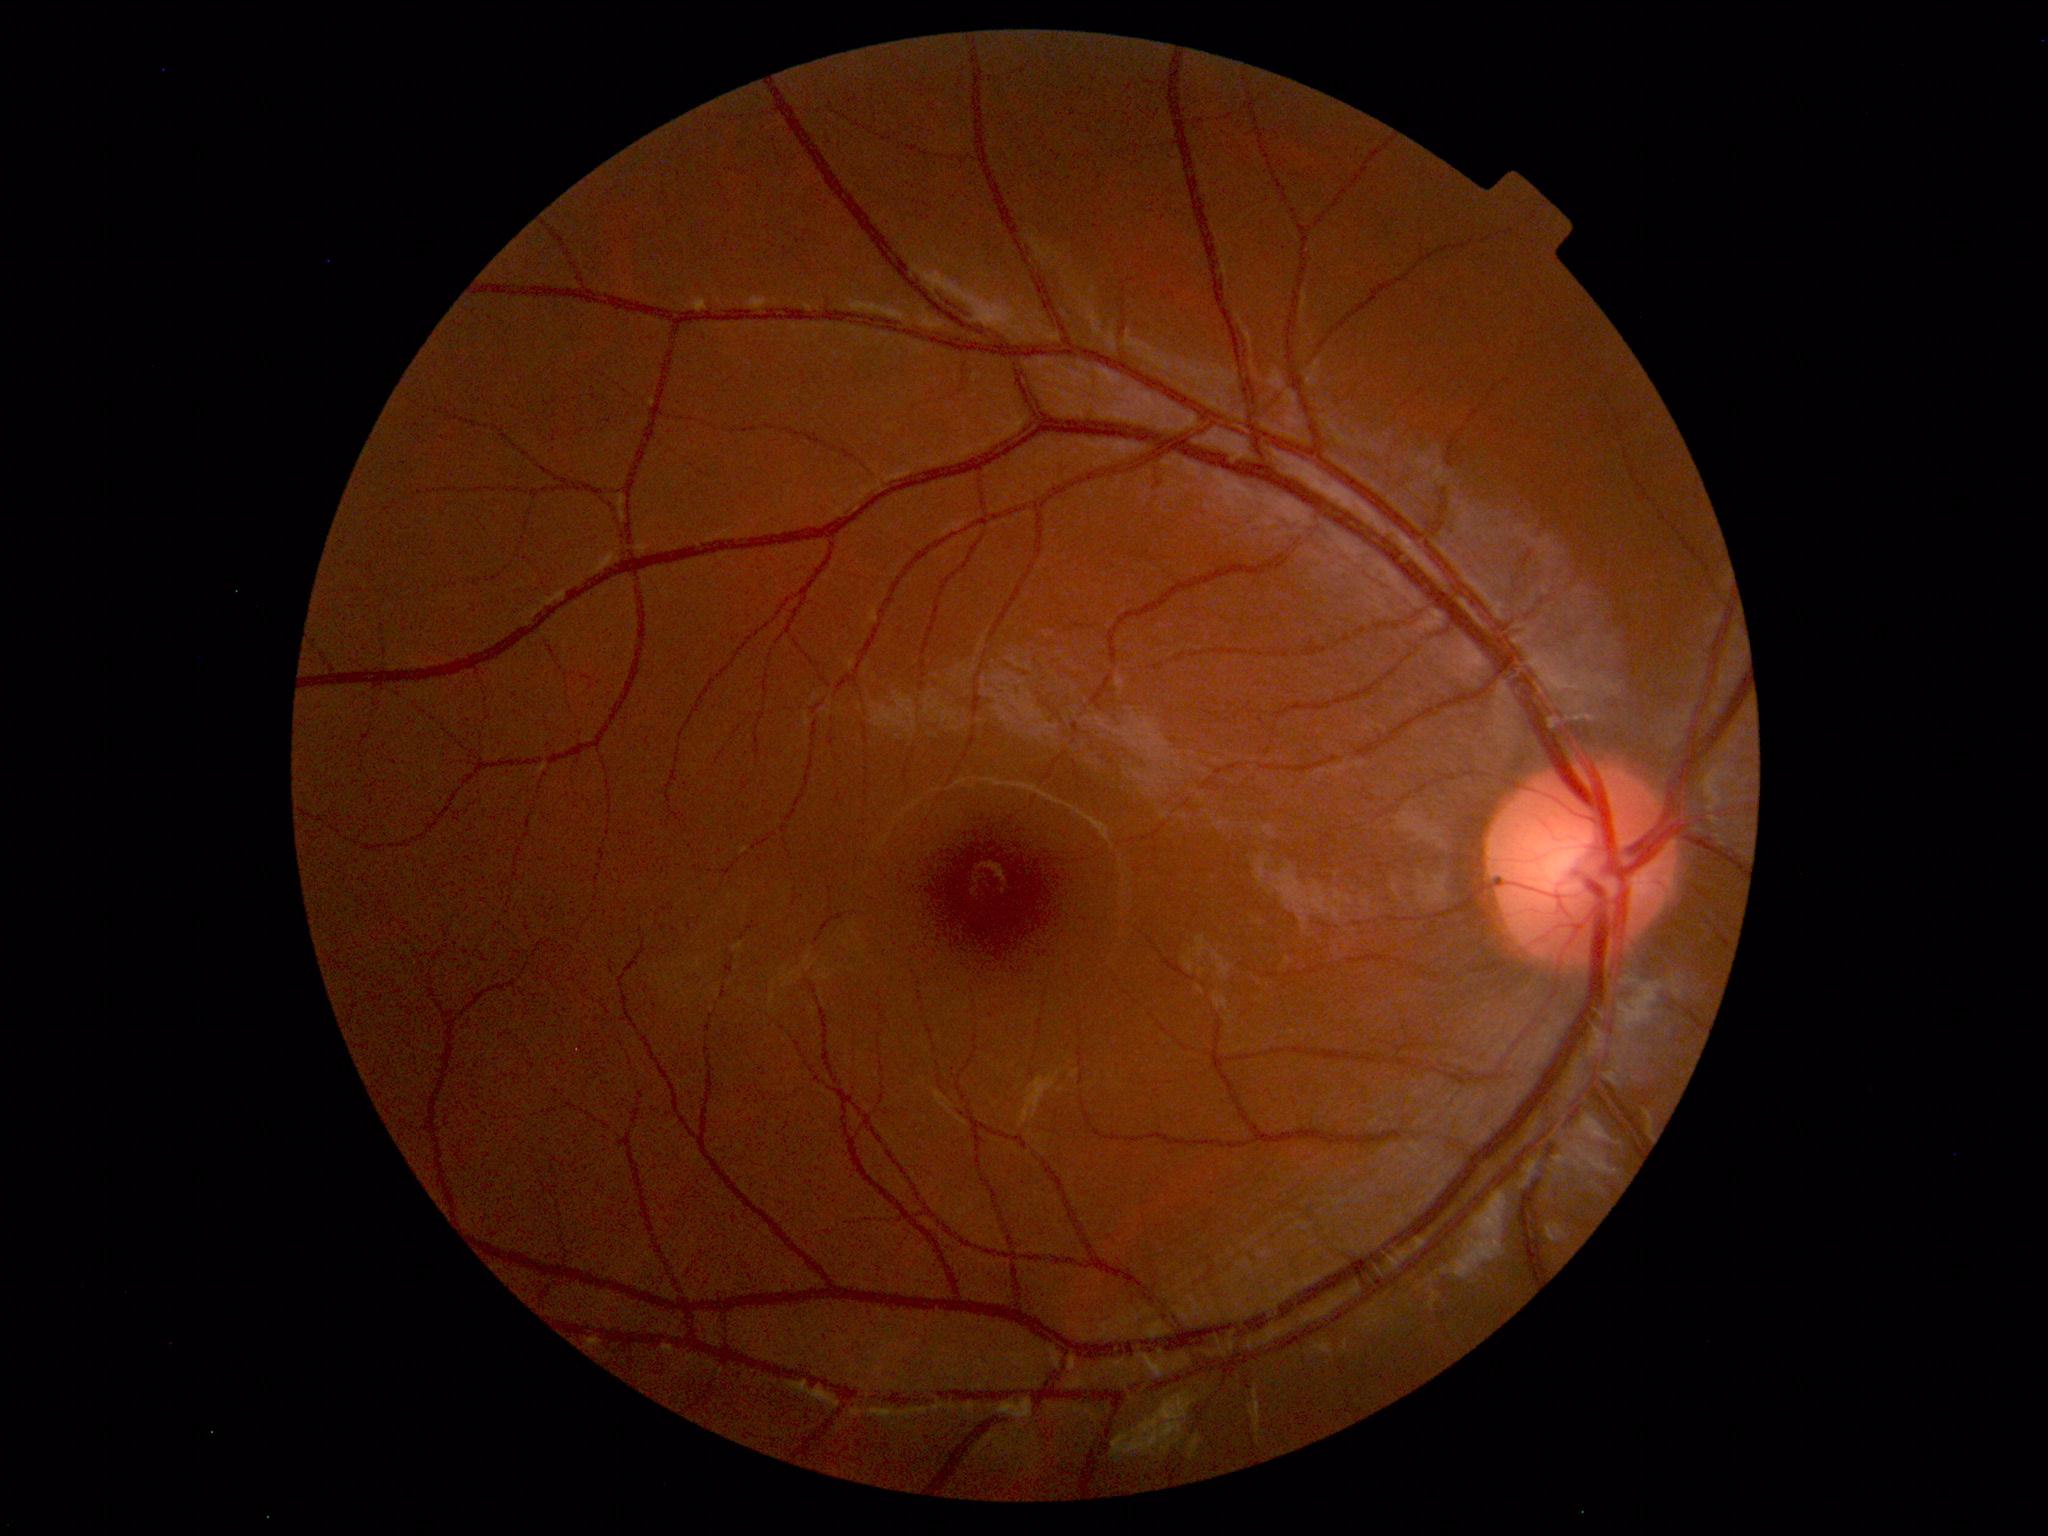 Impression: normal fundus.